Wide-field fundus photograph of an infant — 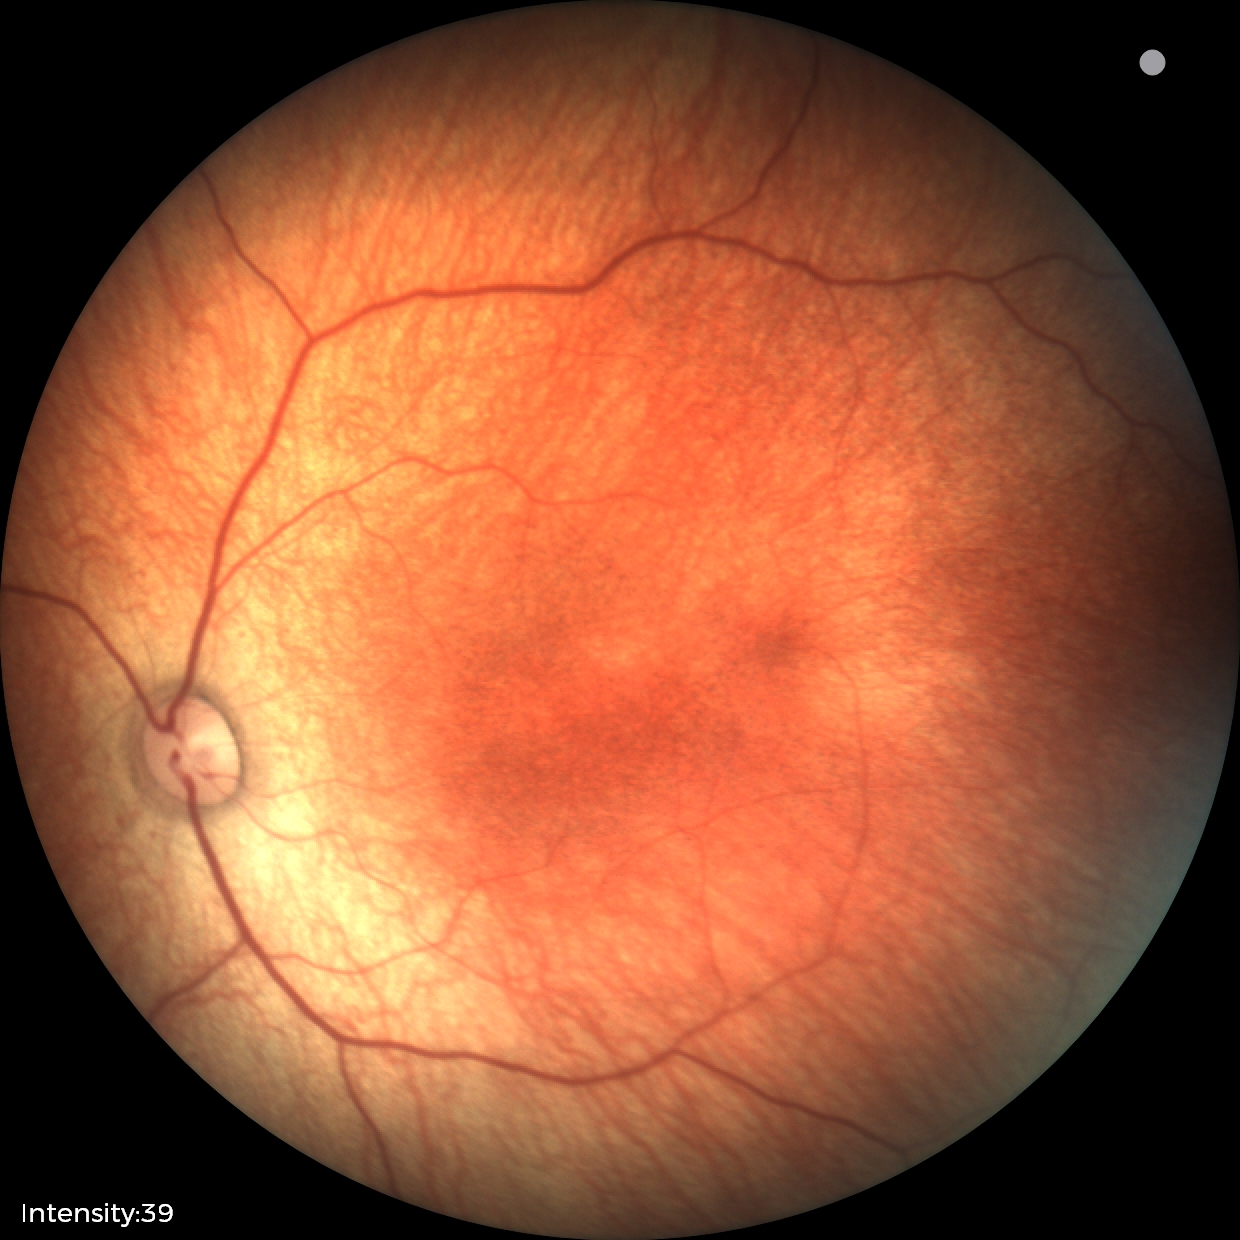 Finding = normal.